Macula-centered field — 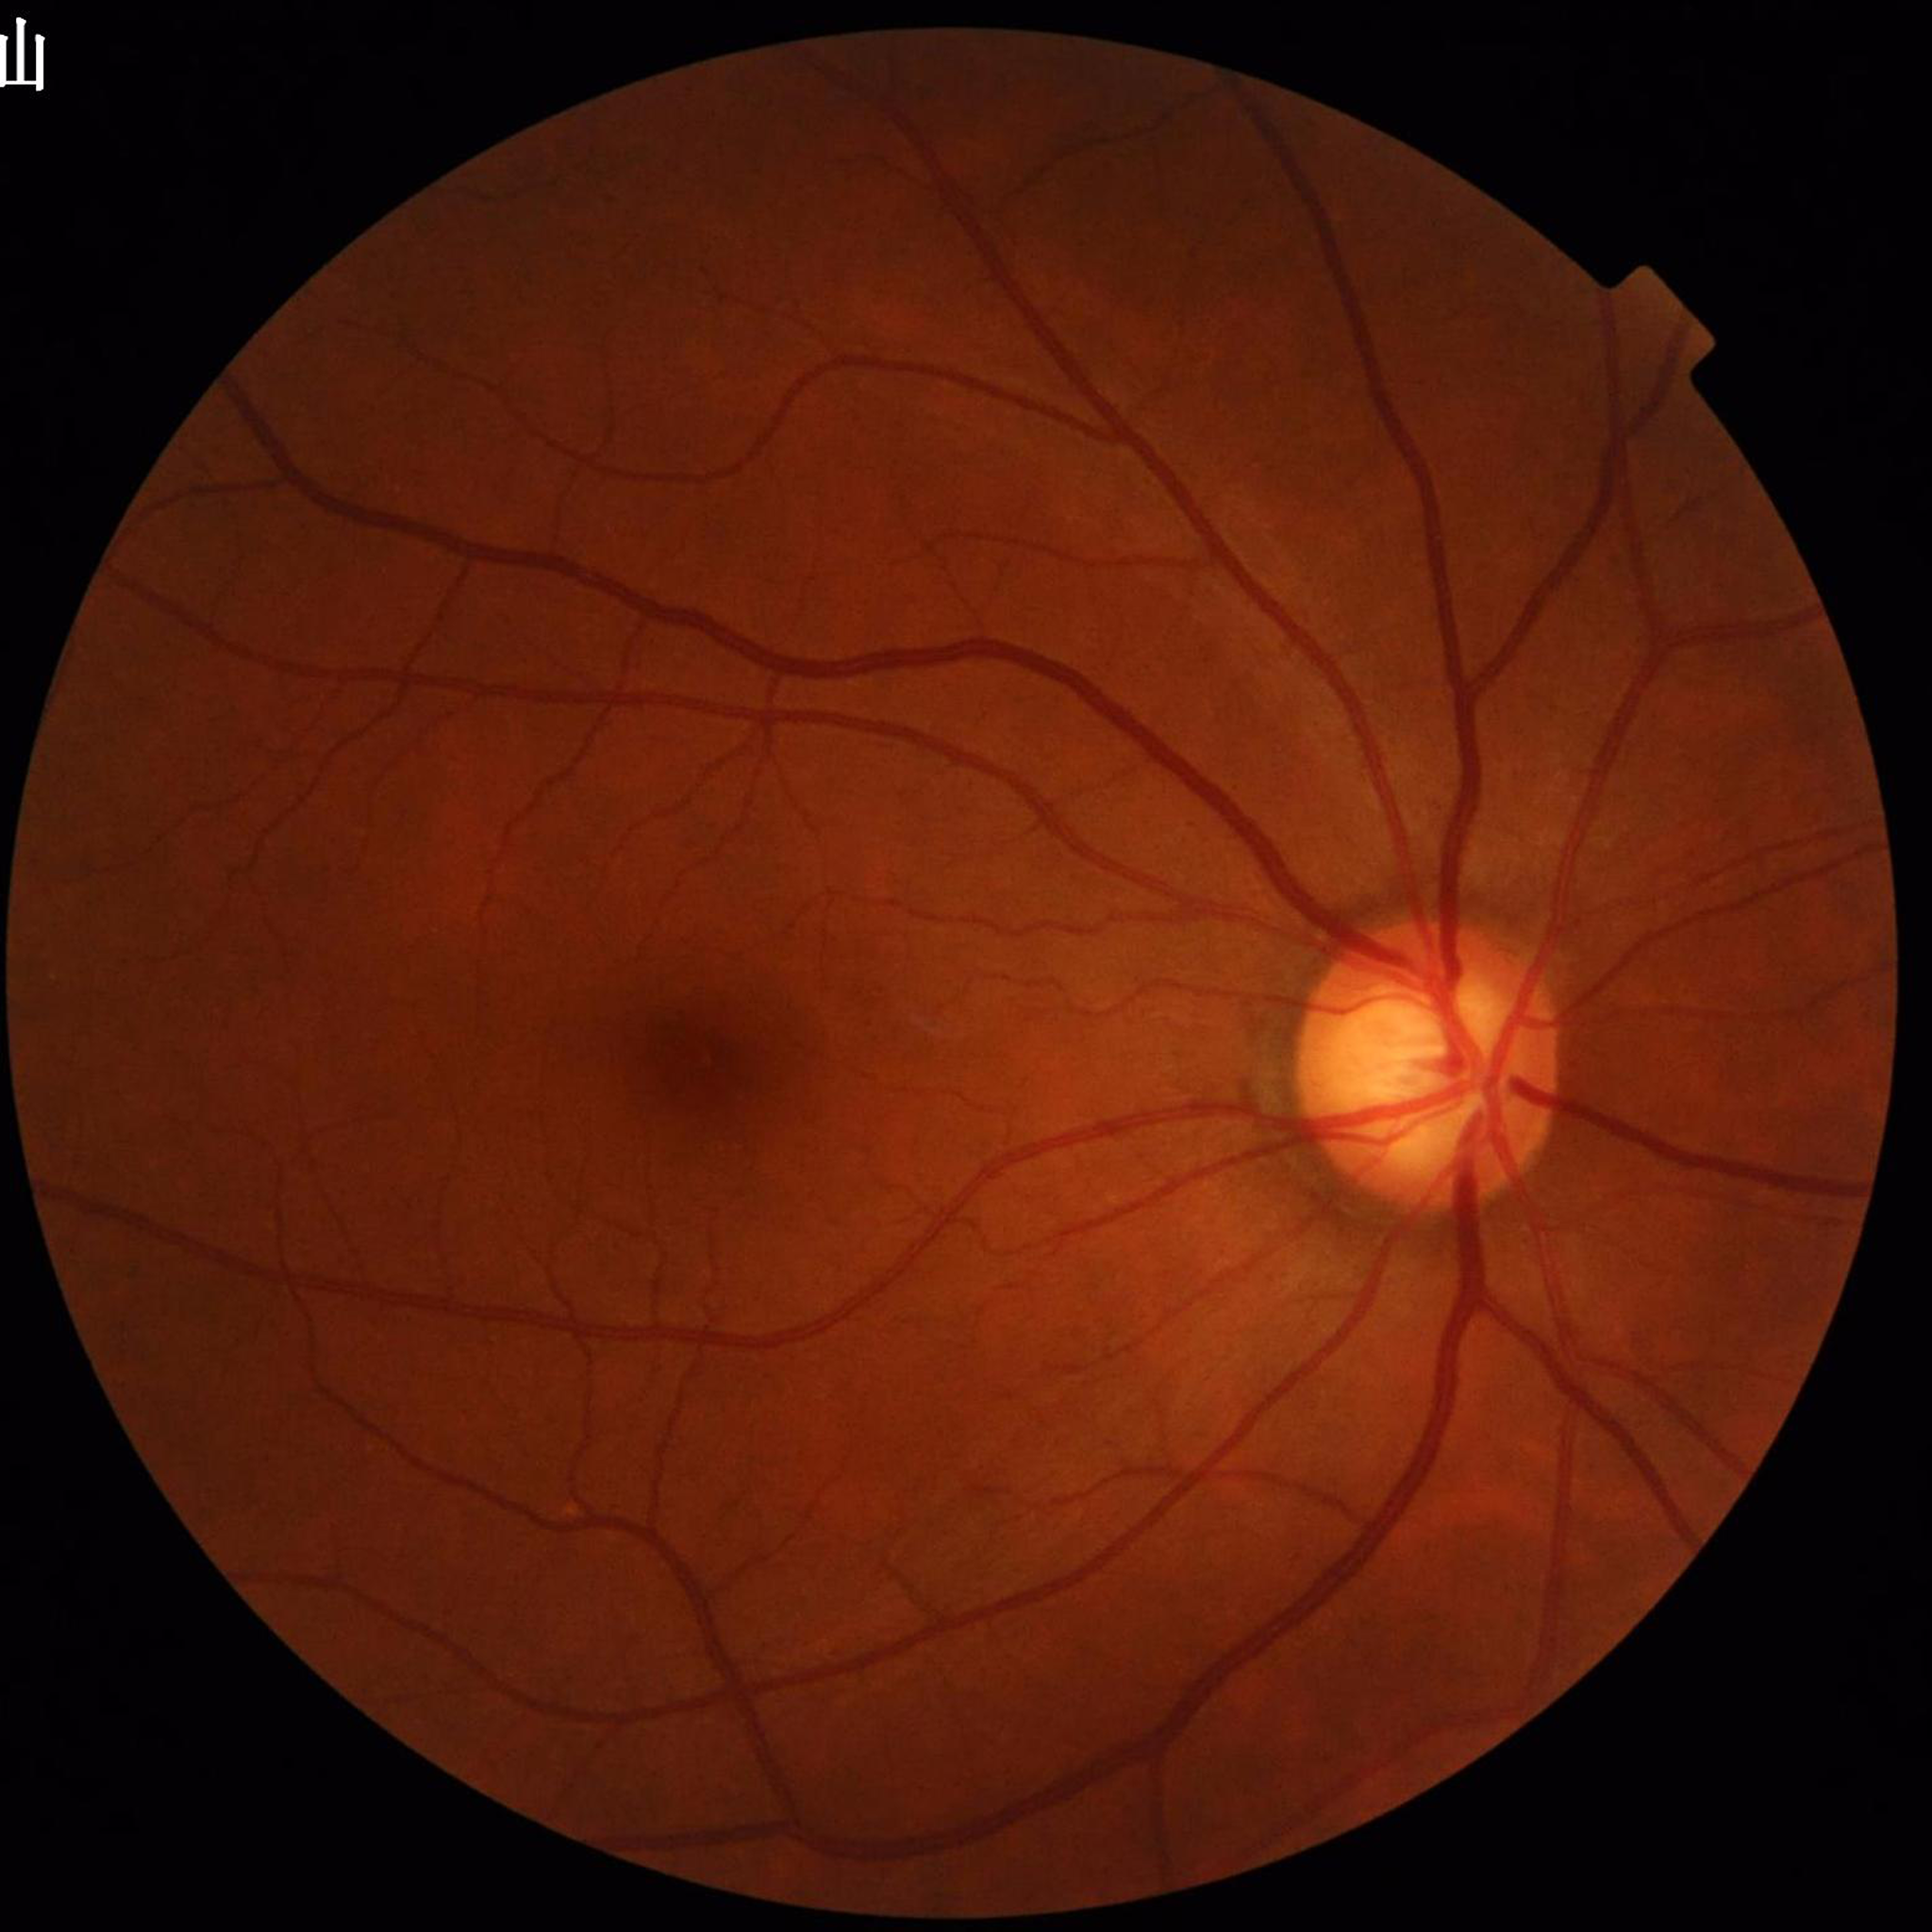
Quality: adequate. Retinal fundus photograph from a patient with glaucoma.